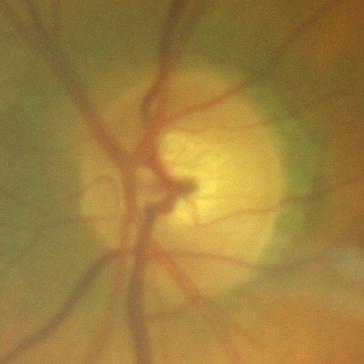 Optic disc appearance consistent with no glaucomatous optic neuropathy.